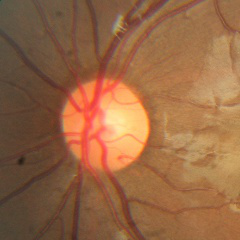
Glaucoma diagnosis: no glaucomatous optic neuropathy.